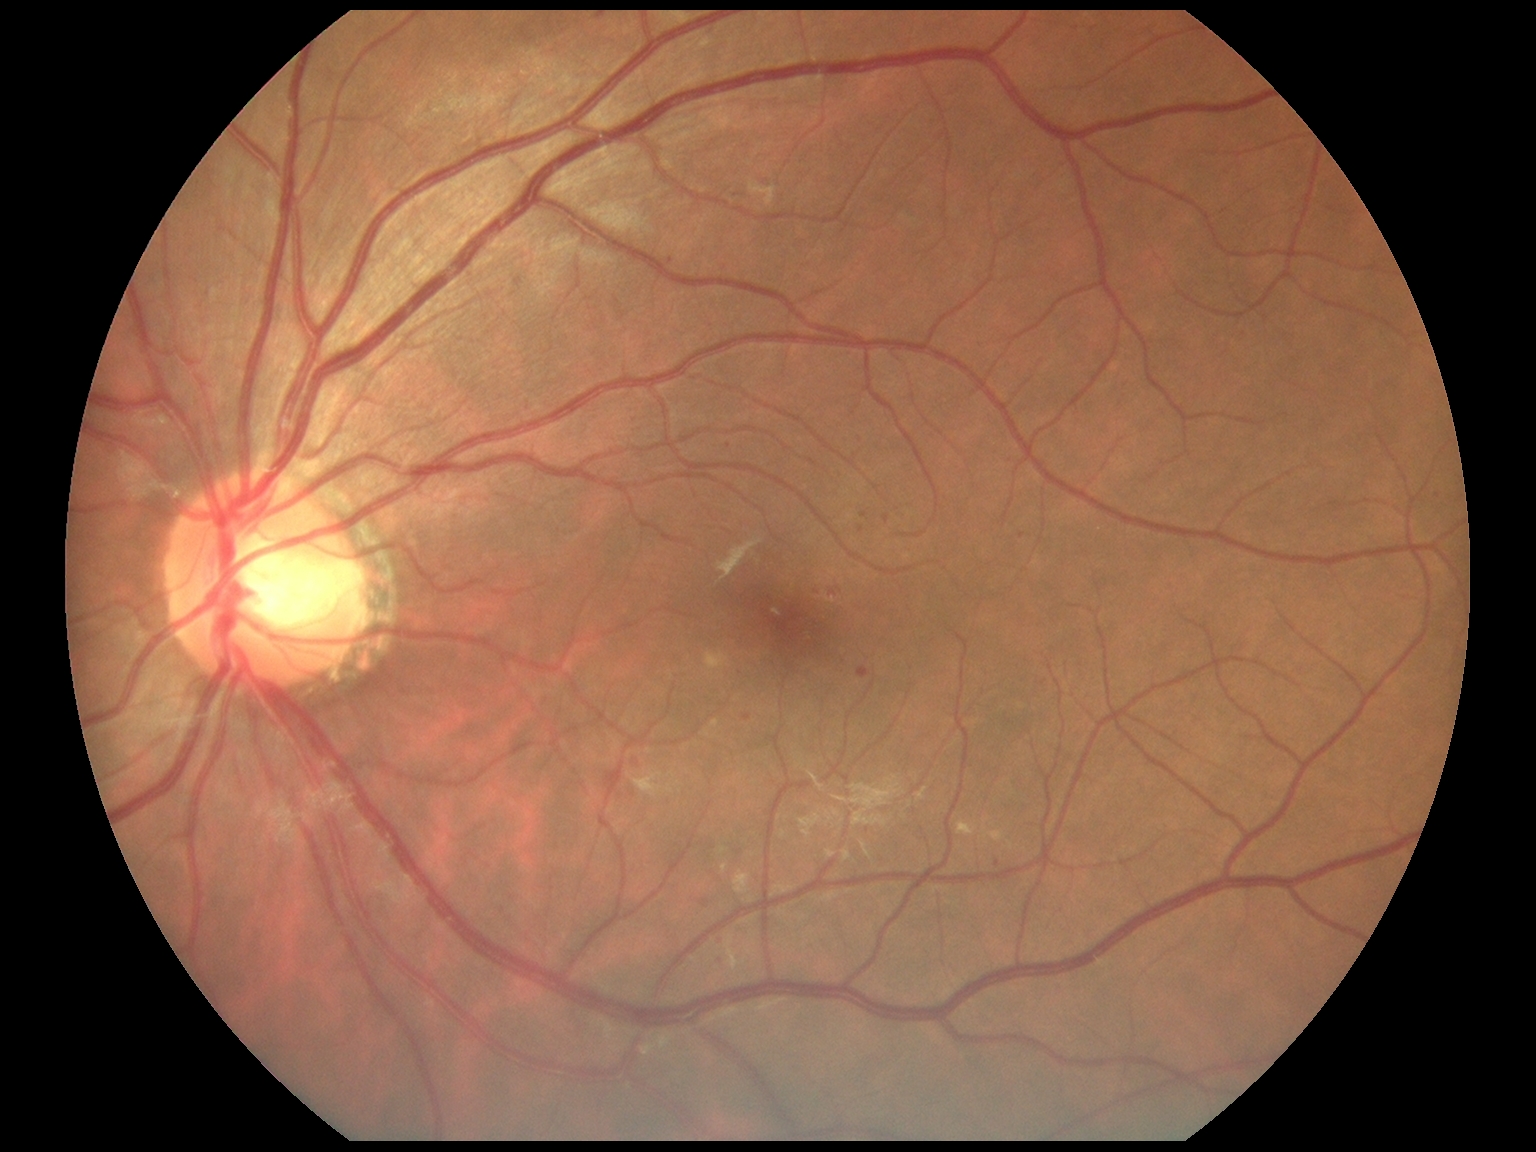
Diabetic retinopathy severity: moderate NPDR (grade 2) — more than just microaneurysms but less than severe NPDR
A subset of detected lesions:
- soft exudates: none detected
- hemorrhages: none detected
- hard exudates: [985,832,1005,842] | [706,651,731,672] | [957,823,976,837]
- microaneurysms (partial): [883,515,890,525] | [636,758,647,768] | [515,278,523,287] | [857,668,871,680] | [720,938,726,946] | [714,955,724,967]
- Smaller microaneurysms around <point>998, 864</point> | <point>729, 446</point> | <point>1023, 536</point> | <point>862, 530</point> | <point>1438, 497</point> | <point>737, 196</point> | <point>834, 594</point> | <point>671, 262</point> | <point>864, 515</point> | <point>747, 718</point>